2212 x 1659 pixels; CFP
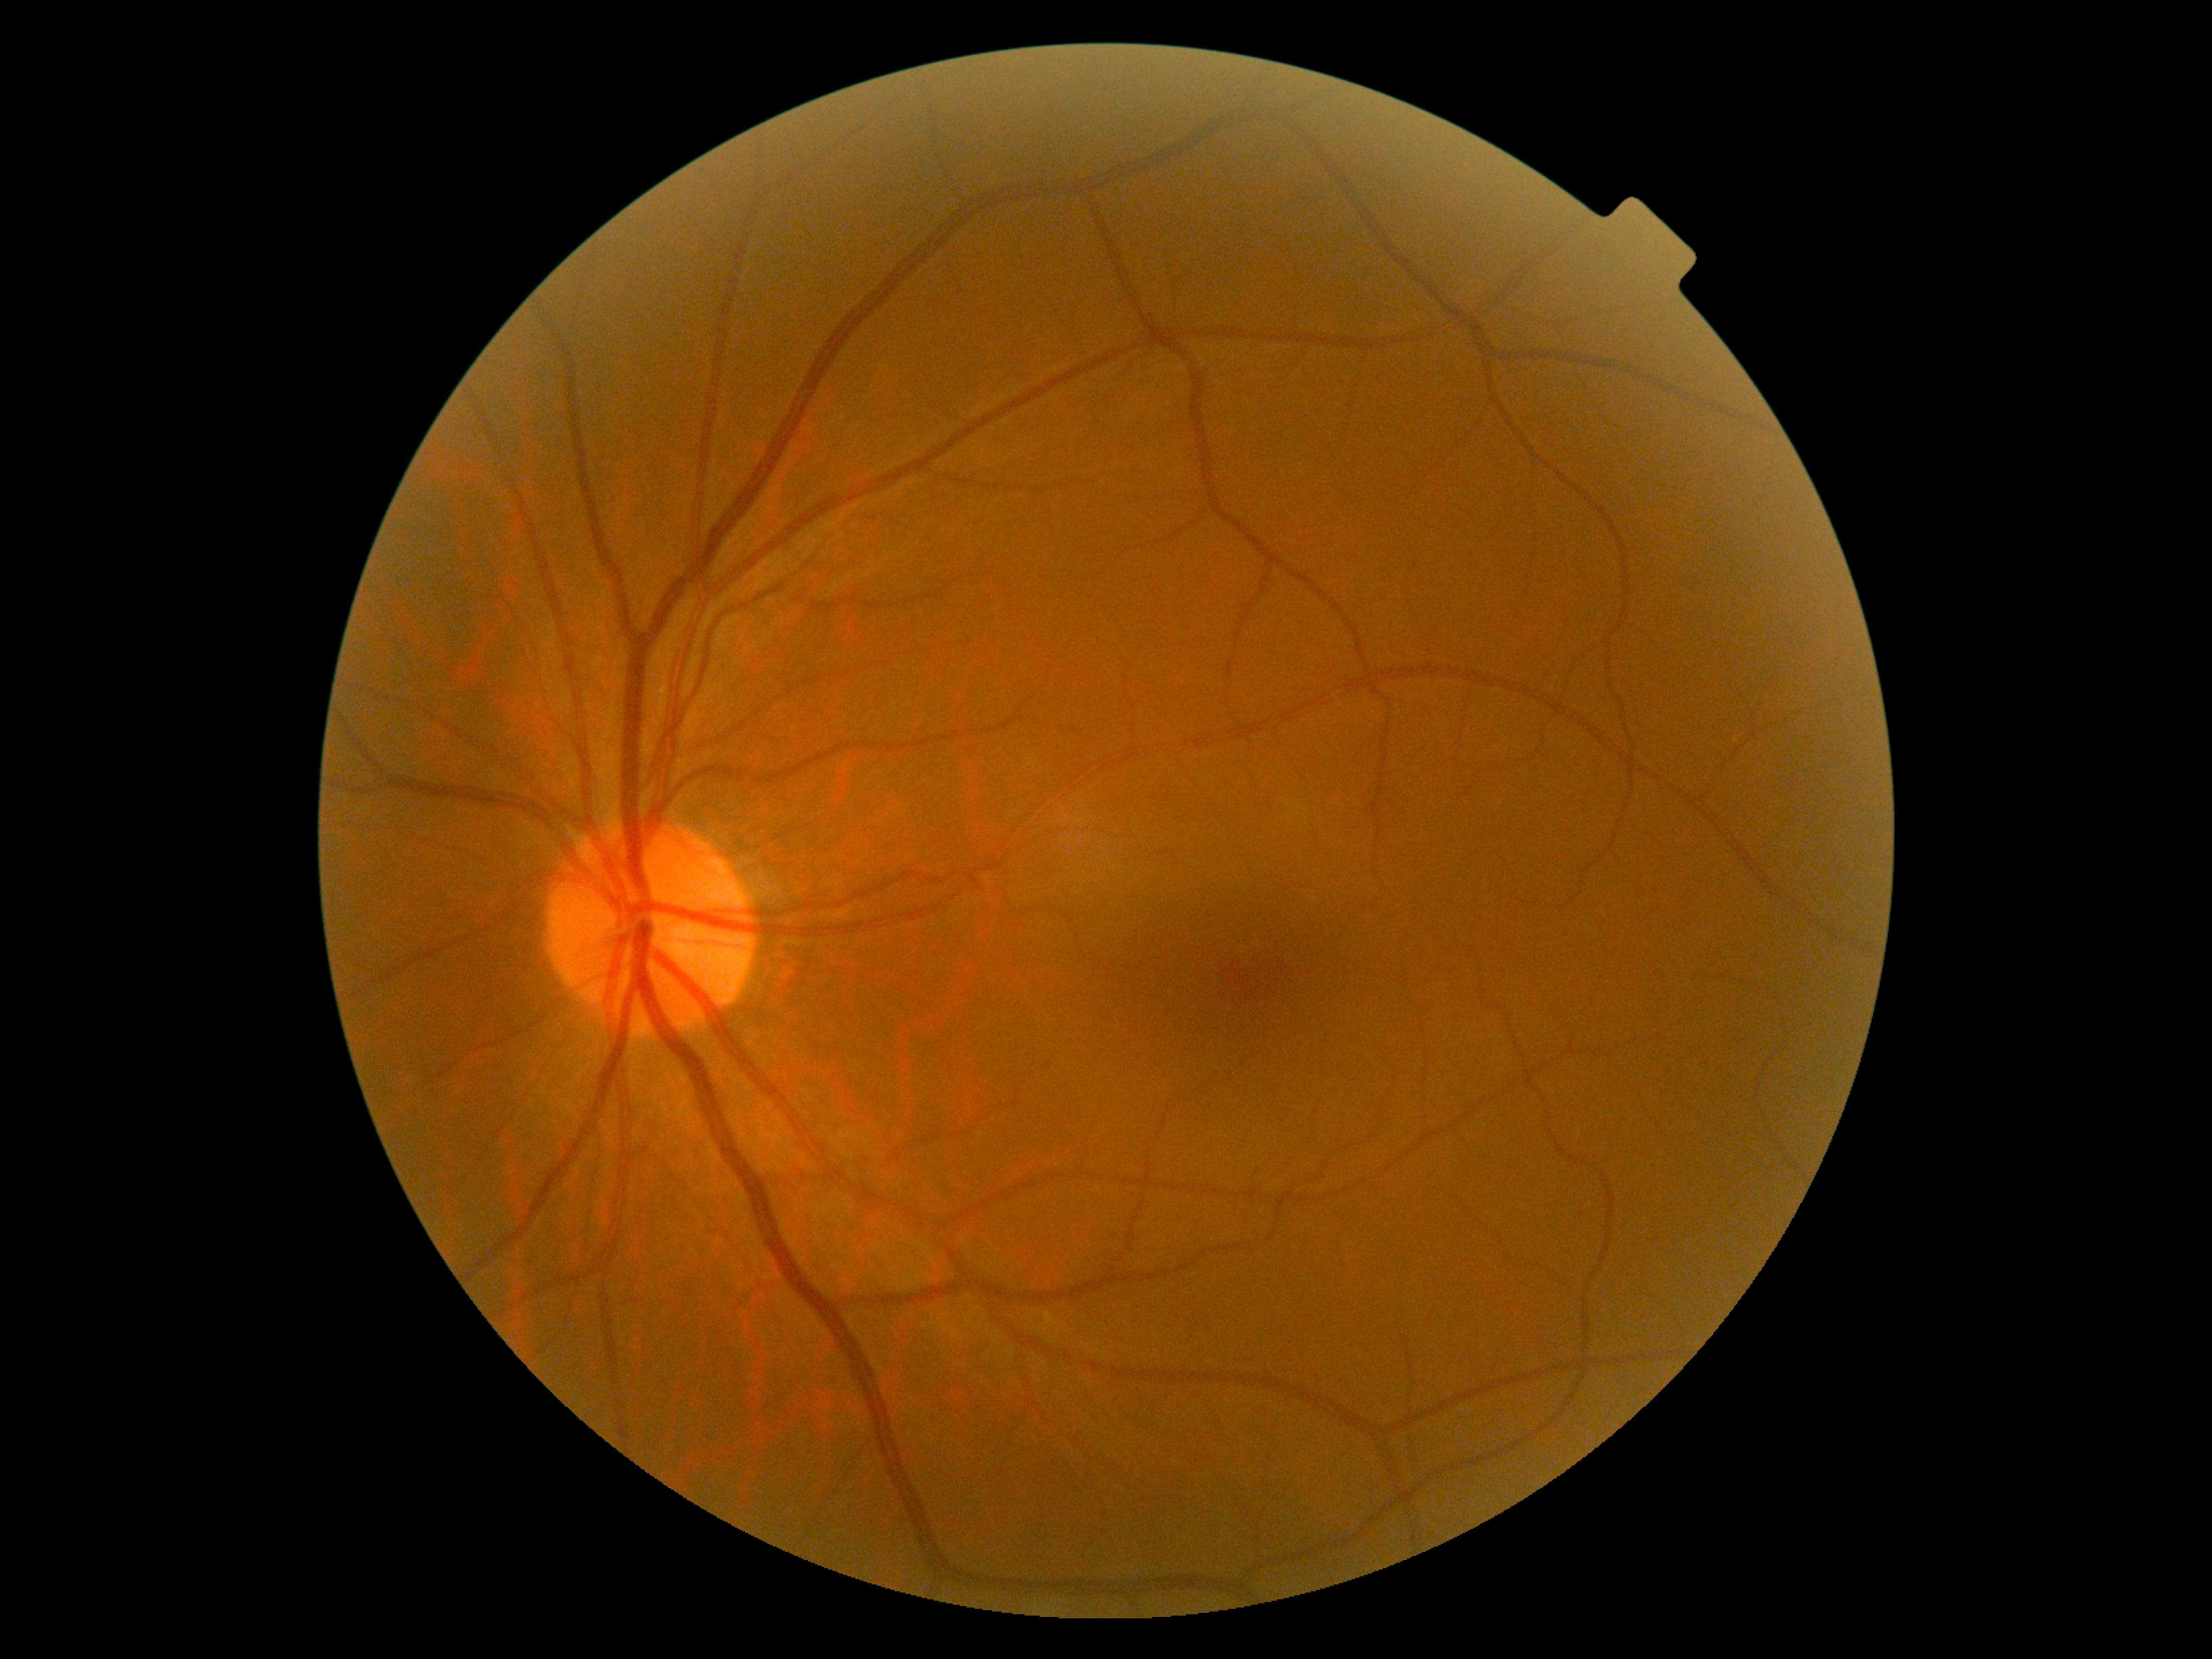
DR stage is grade 0.